Cropped to the optic nerve head · 240 x 240 pixels — 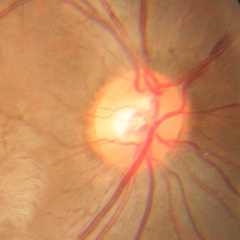
The image shows no glaucomatous optic neuropathy.